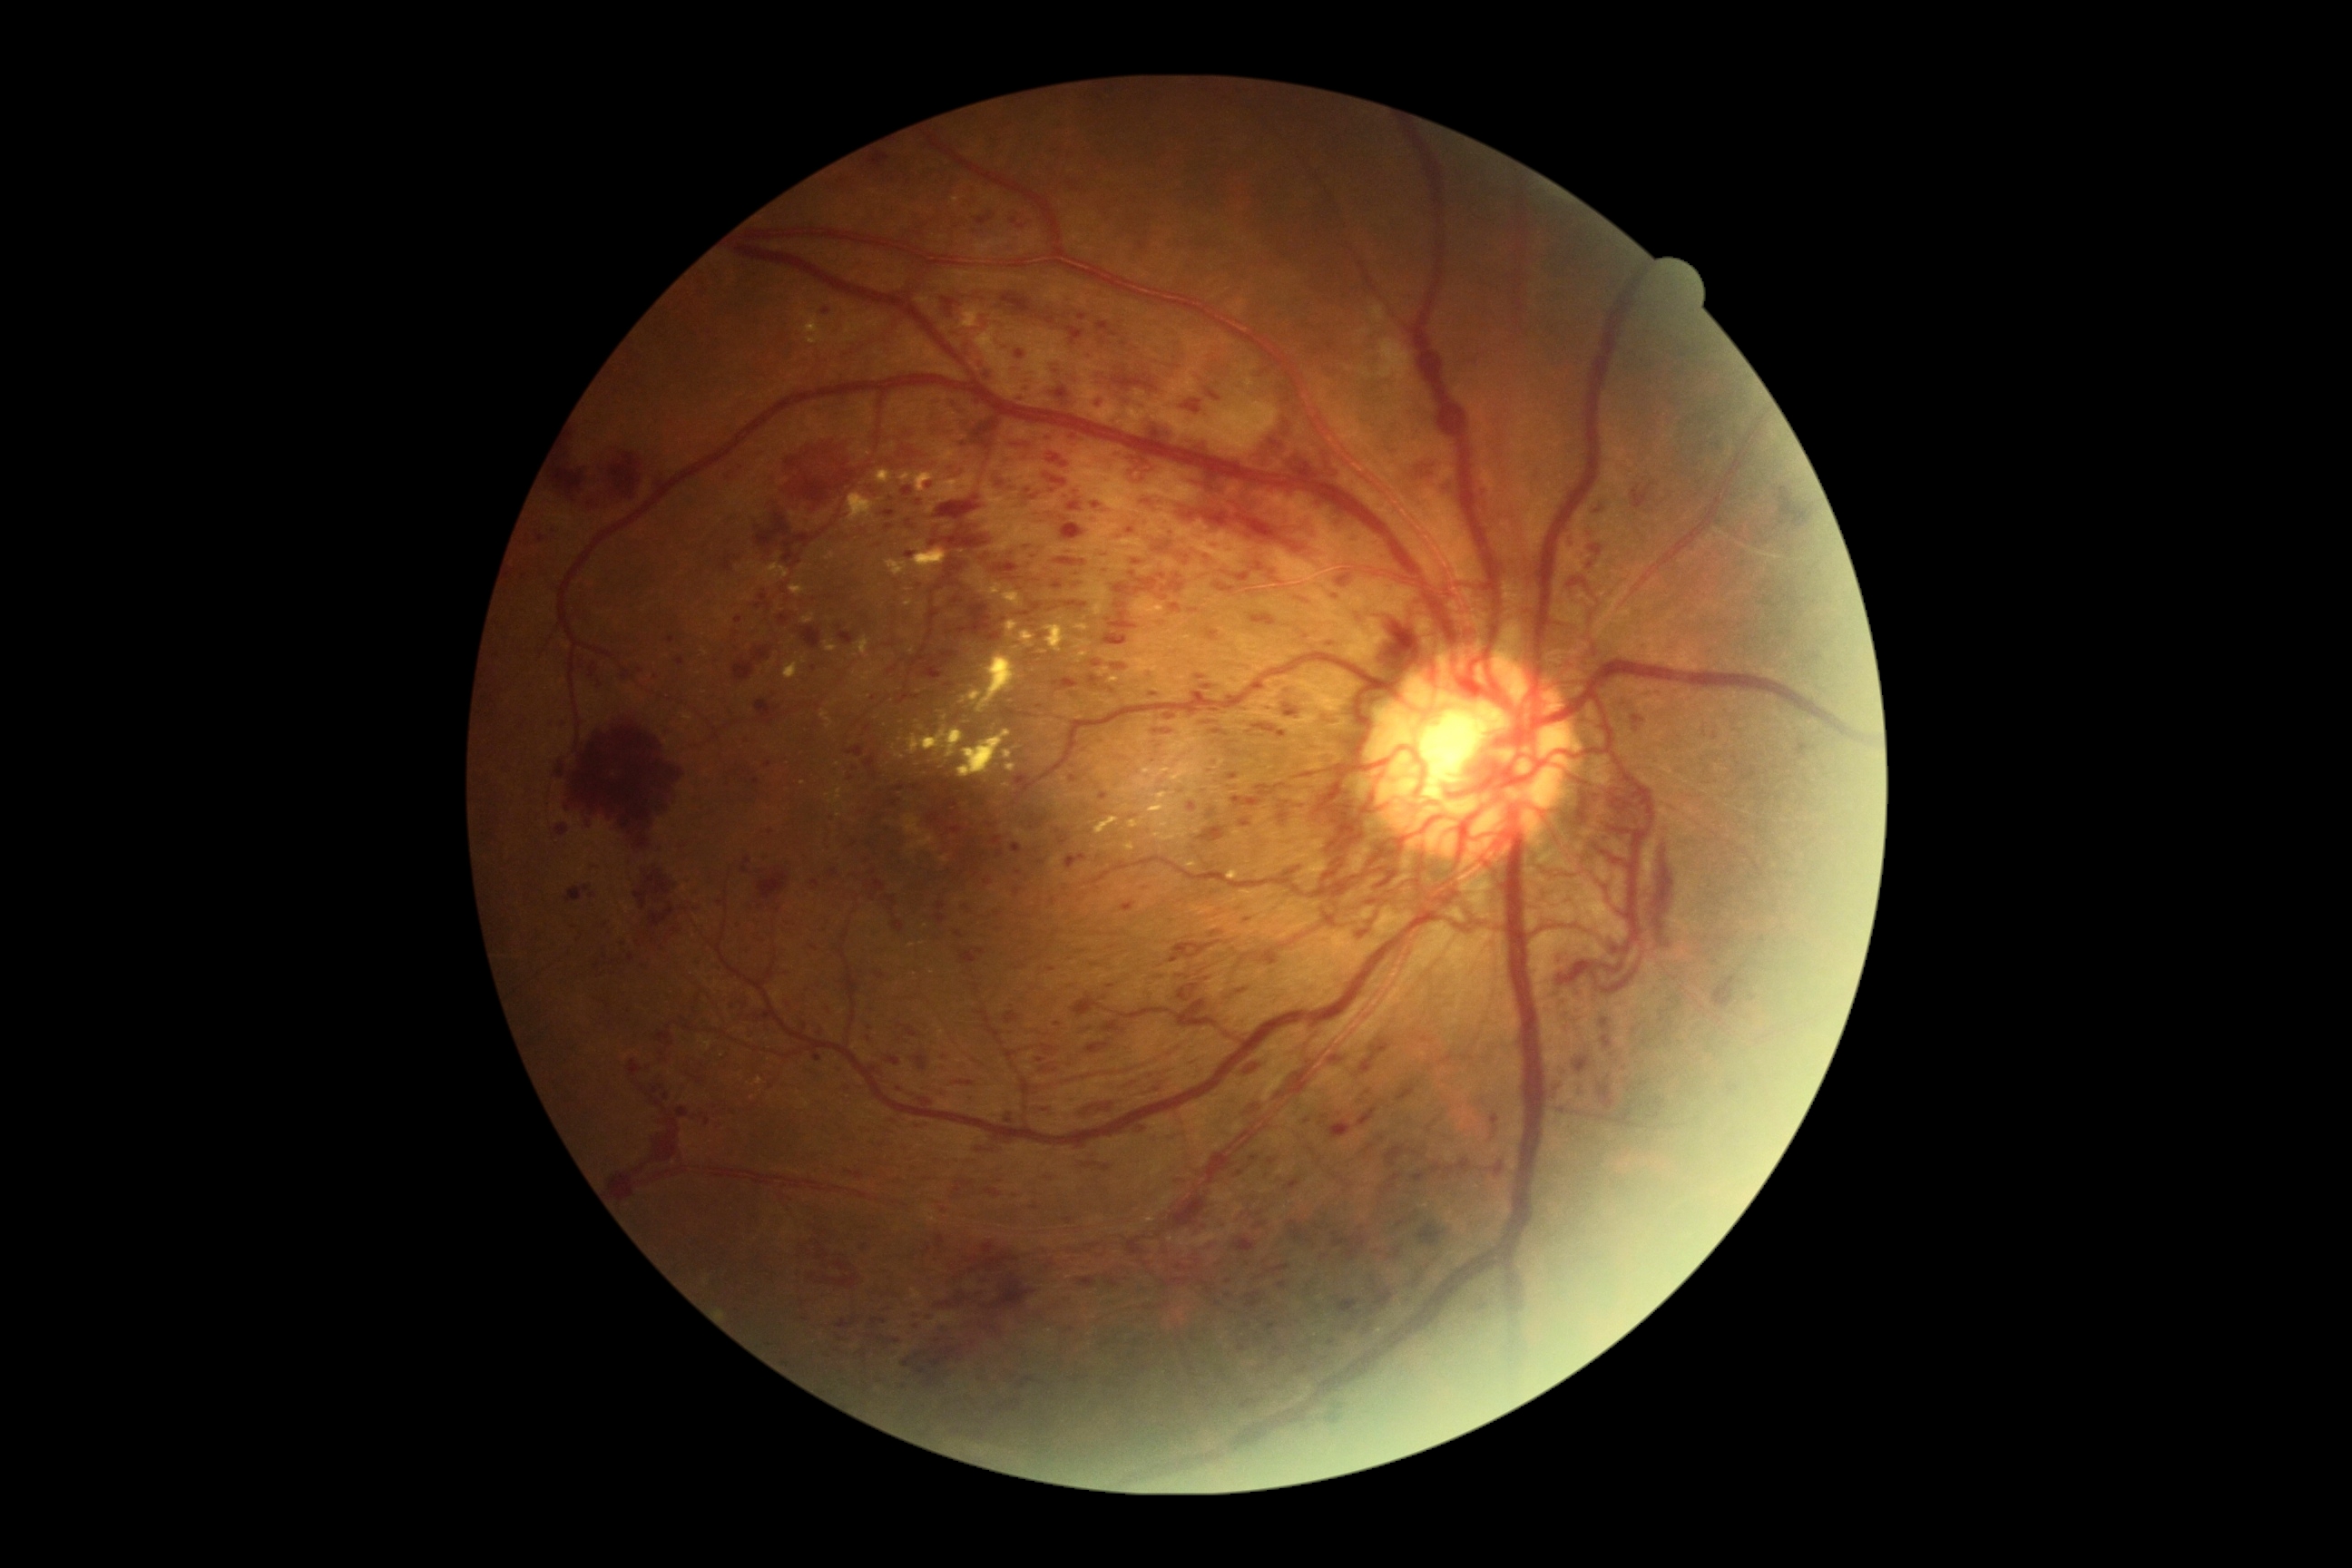 DR severity: 4/4; proliferative diabetic retinopathy
Selected lesions:
MAs (subset): l=536, t=534, r=545, b=544 | l=1014, t=774, r=1028, b=787 | l=1197, t=676, r=1210, b=681 | l=1012, t=843, r=1023, b=854 | l=1092, t=518, r=1101, b=524 | l=696, t=995, r=701, b=1004 | l=1070, t=776, r=1079, b=783 | l=663, t=1093, r=671, b=1101 | l=954, t=930, r=965, b=939
MAs (small, approximate centers) near (1099; 859) | (831; 598) | (878; 546) | (1125; 344) | (1000; 484) | (656; 678) | (991; 825) | (1053; 491)
HEs (subset): l=1569, t=529, r=1578, b=547 | l=1364, t=1041, r=1391, b=1079 | l=1239, t=818, r=1251, b=828 | l=1204, t=627, r=1220, b=642 | l=836, t=1317, r=858, b=1329 | l=858, t=1349, r=867, b=1358 | l=1233, t=1239, r=1257, b=1253 | l=1369, t=1289, r=1395, b=1317 | l=1418, t=1226, r=1442, b=1248 | l=609, t=453, r=643, b=502 | l=1269, t=1159, r=1277, b=1166 | l=956, t=1293, r=970, b=1306 | l=1001, t=1139, r=1015, b=1146 | l=1061, t=525, r=1086, b=542 | l=836, t=1335, r=845, b=1342 | l=1246, t=407, r=1324, b=487
HEs (small, approximate centers) near (1632; 1105) | (944; 1058) | (904; 1387)